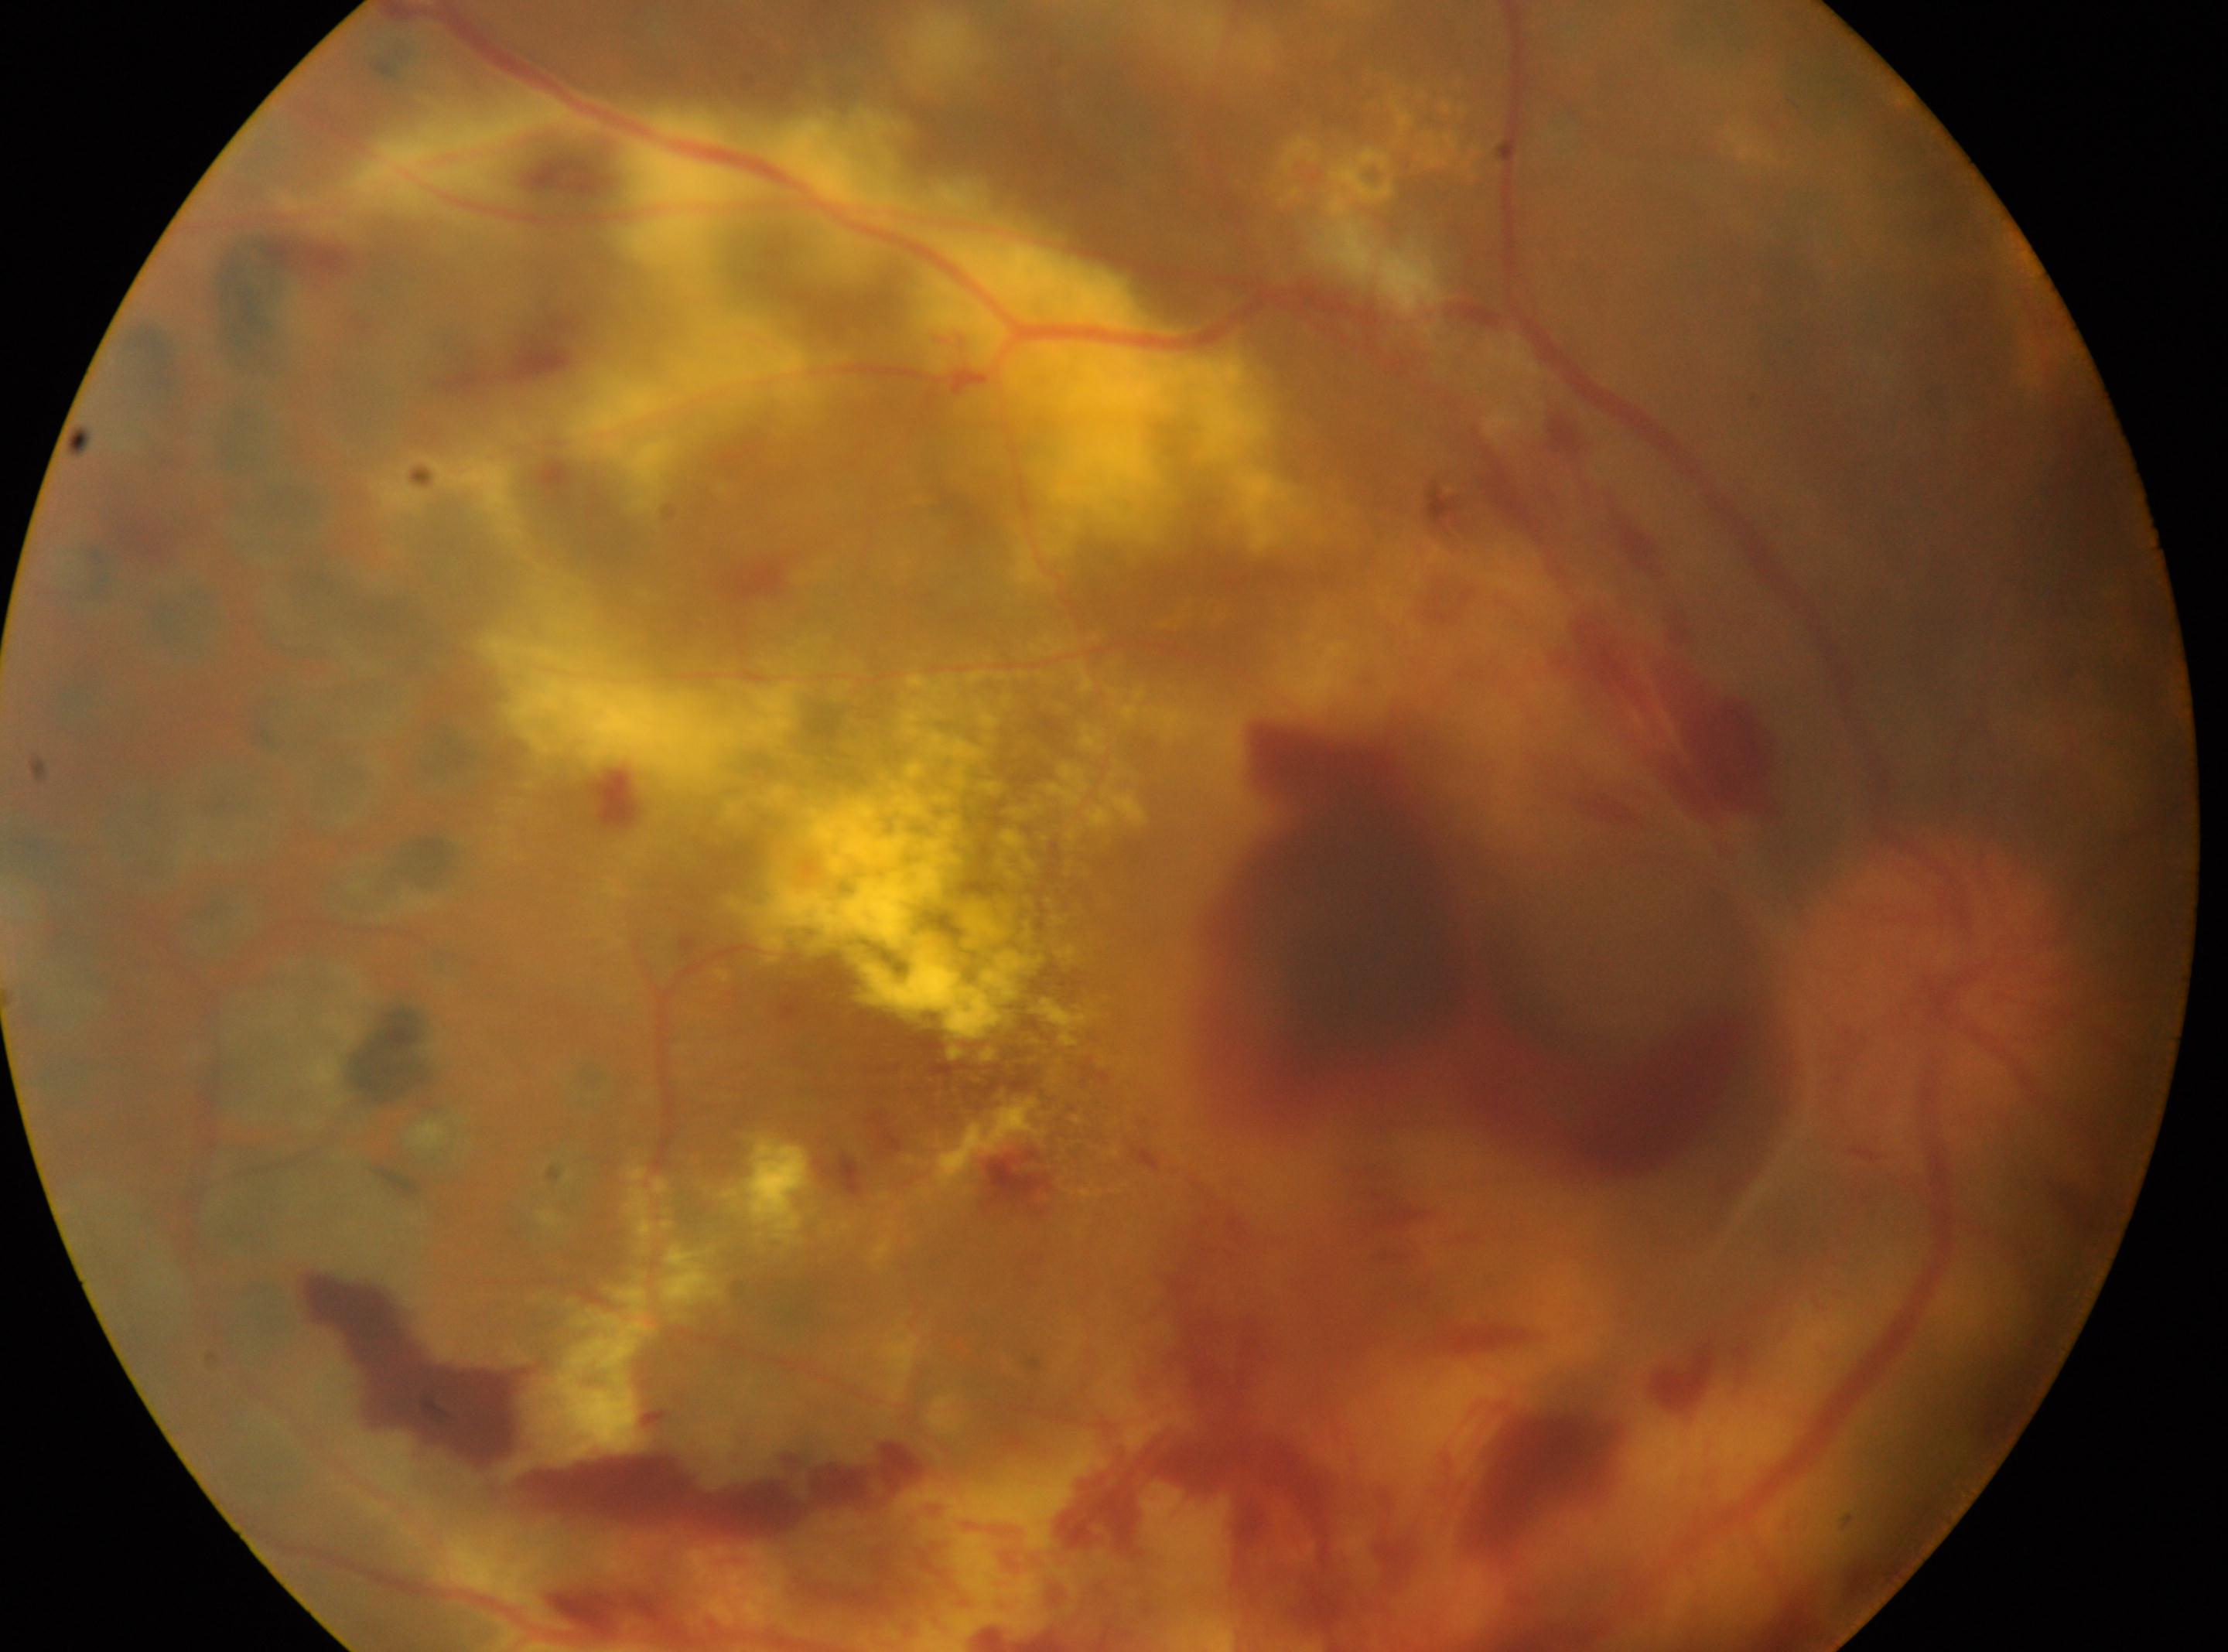

This is the right eye.
The optic disc is at (x: 1920, y: 998).
Diabetic retinopathy (DR) is laser-treated DR, underlying severity PDR (grade 4).
The fovea centralis is at (x: 1018, y: 1072).